Centered on the optic disc; color fundus image — 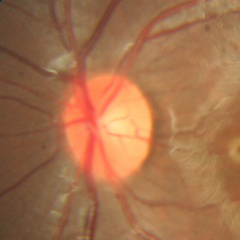
There is evidence of no signs of glaucoma.